2212 by 1659 pixels; CFP; 45° FOV
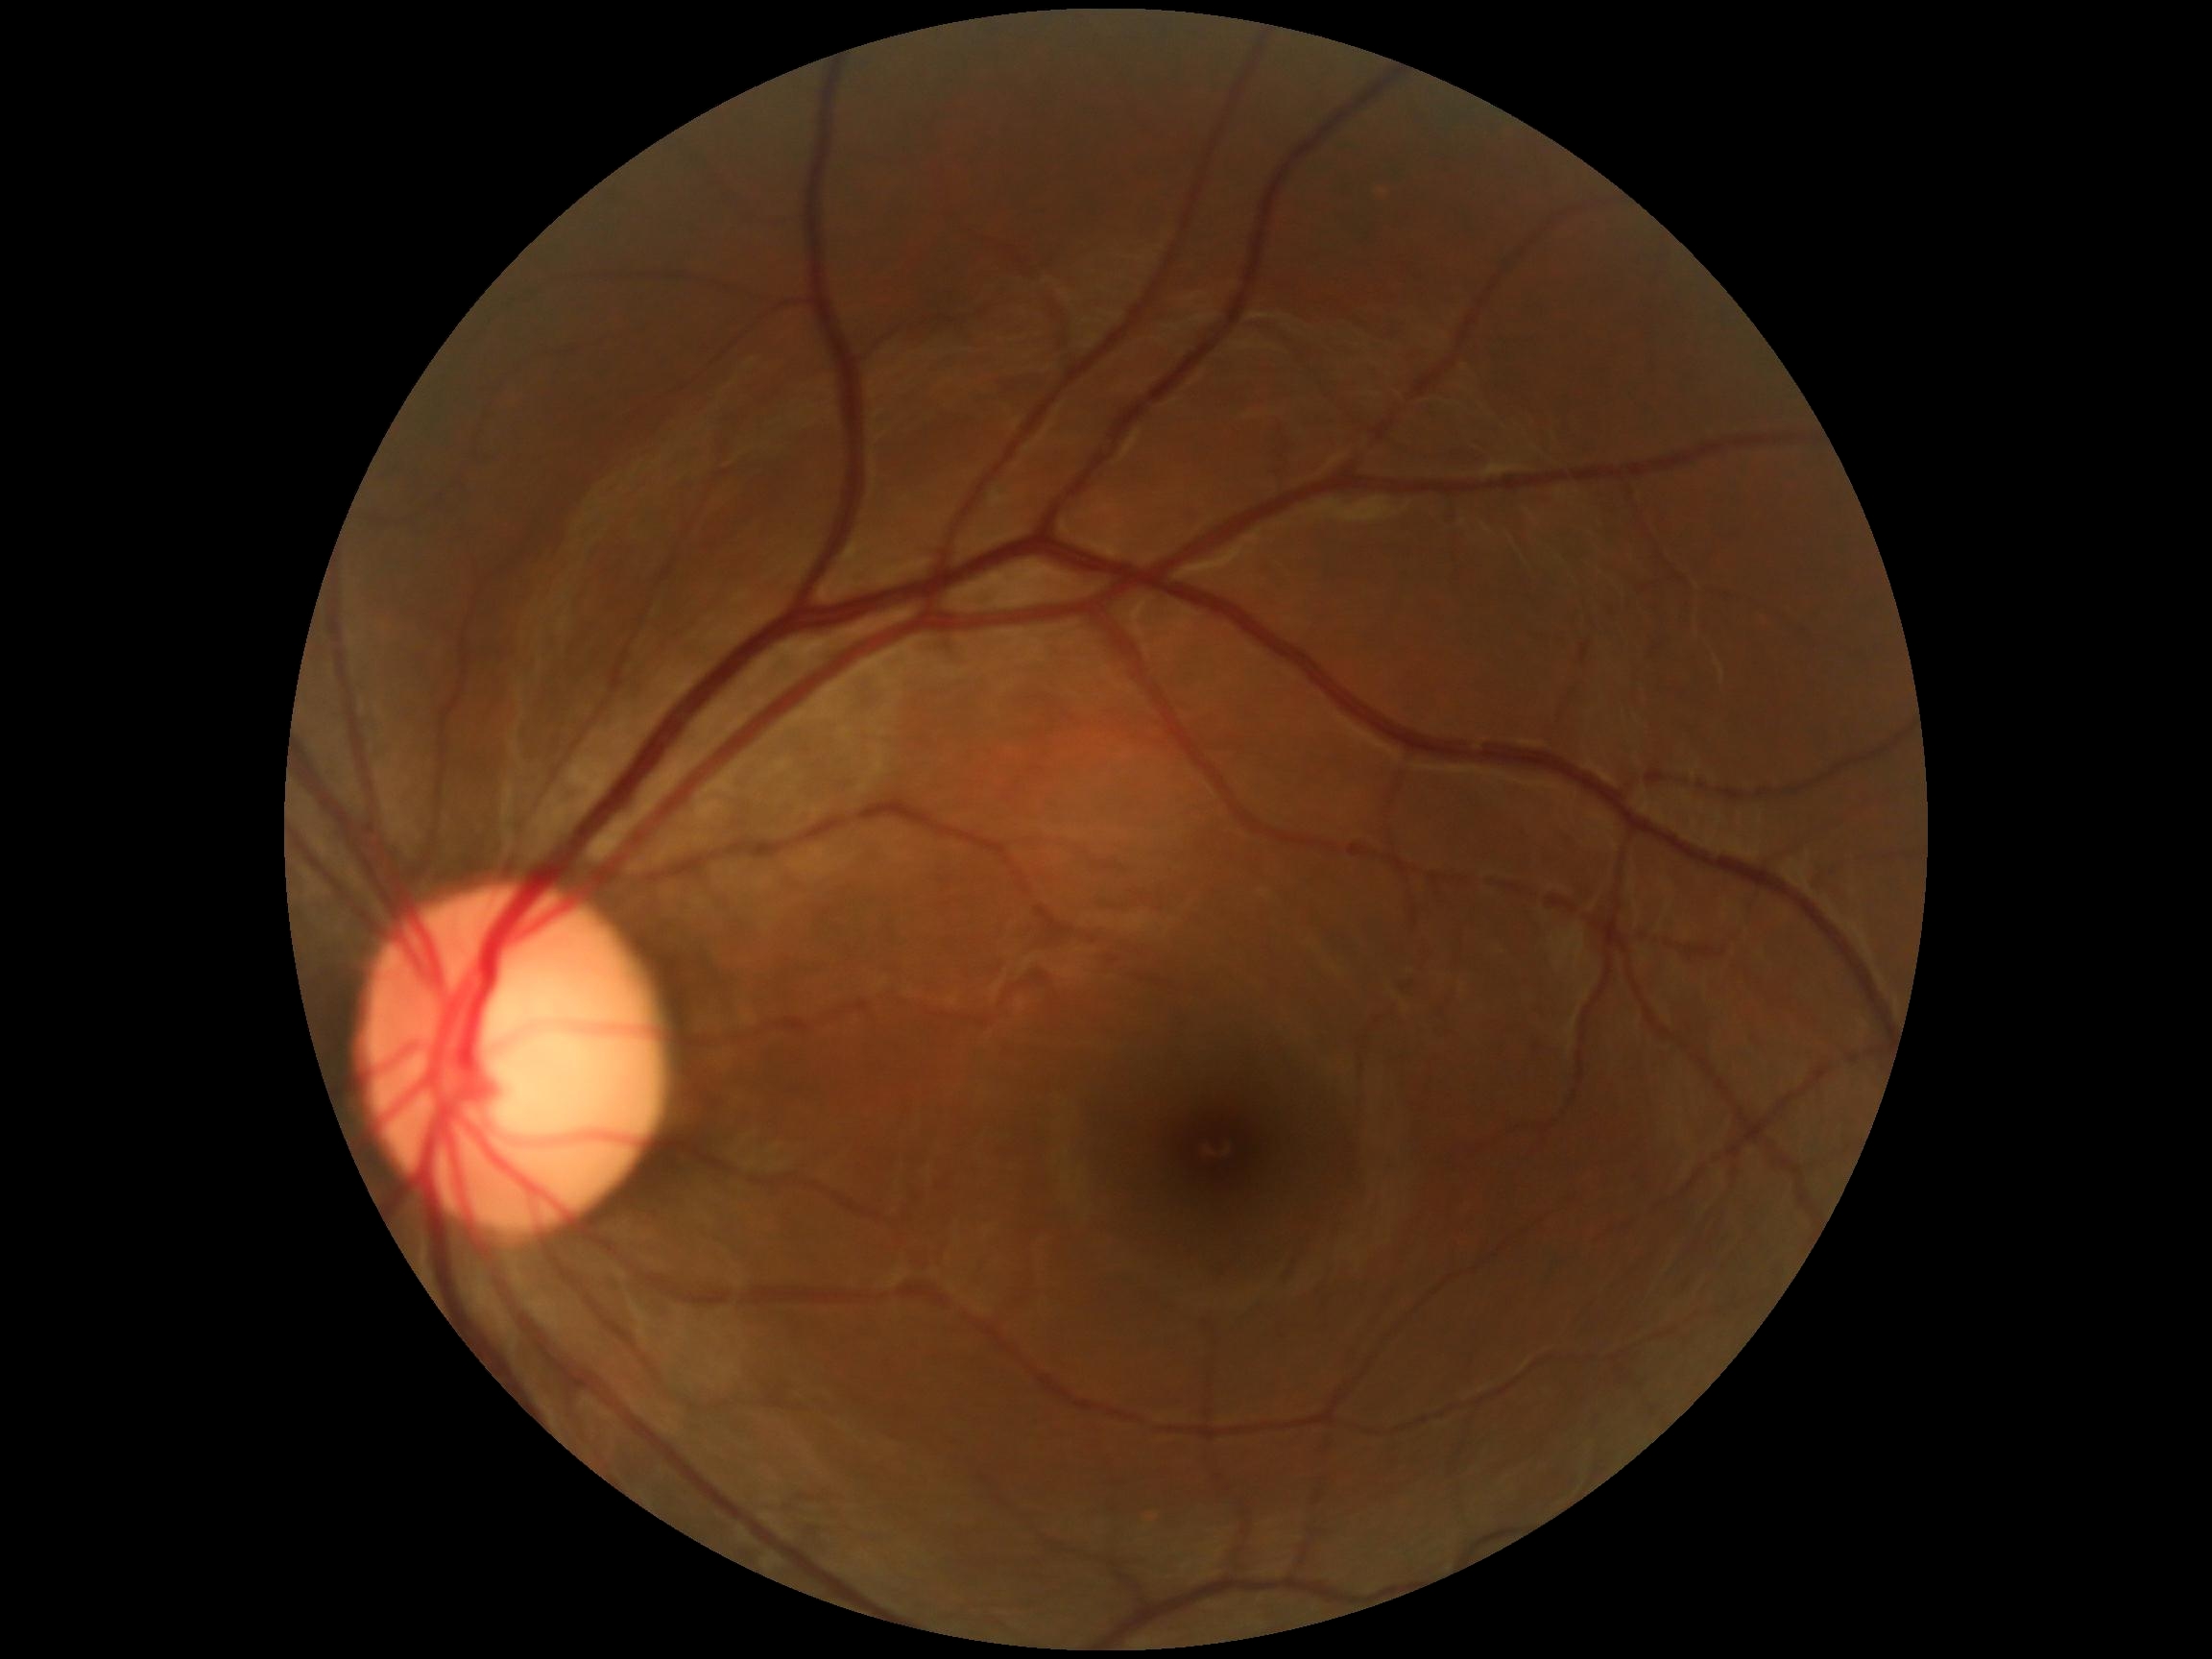 DR is no apparent diabetic retinopathy (grade 0).